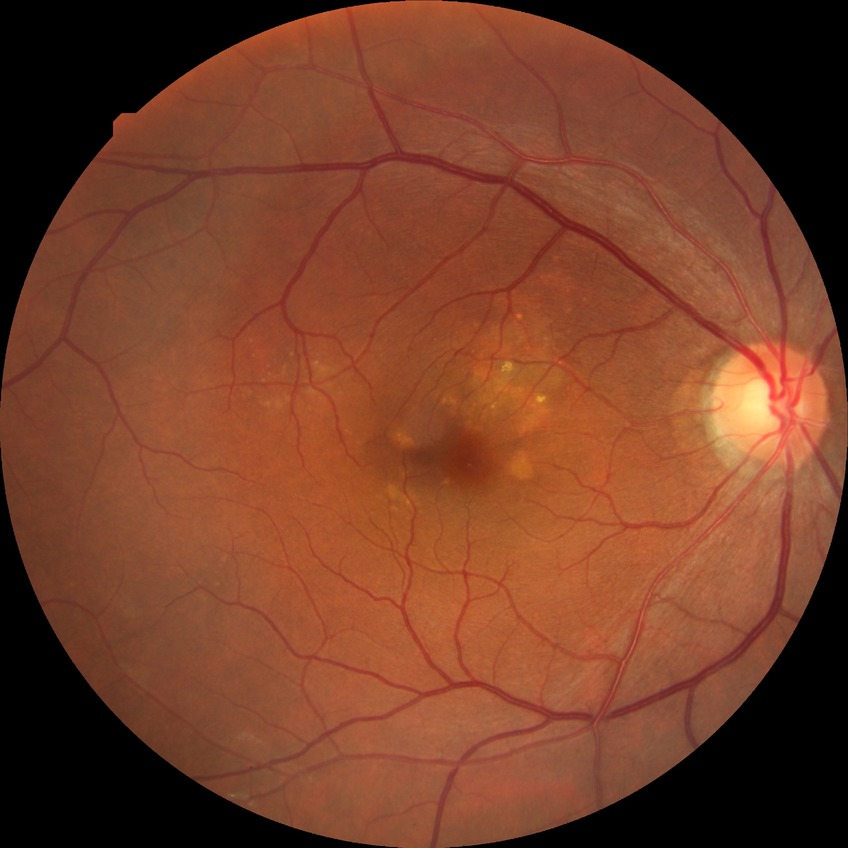
Diabetic retinopathy stage is no diabetic retinopathy.